45° FOV. CFP. 1380 by 1382 pixels.
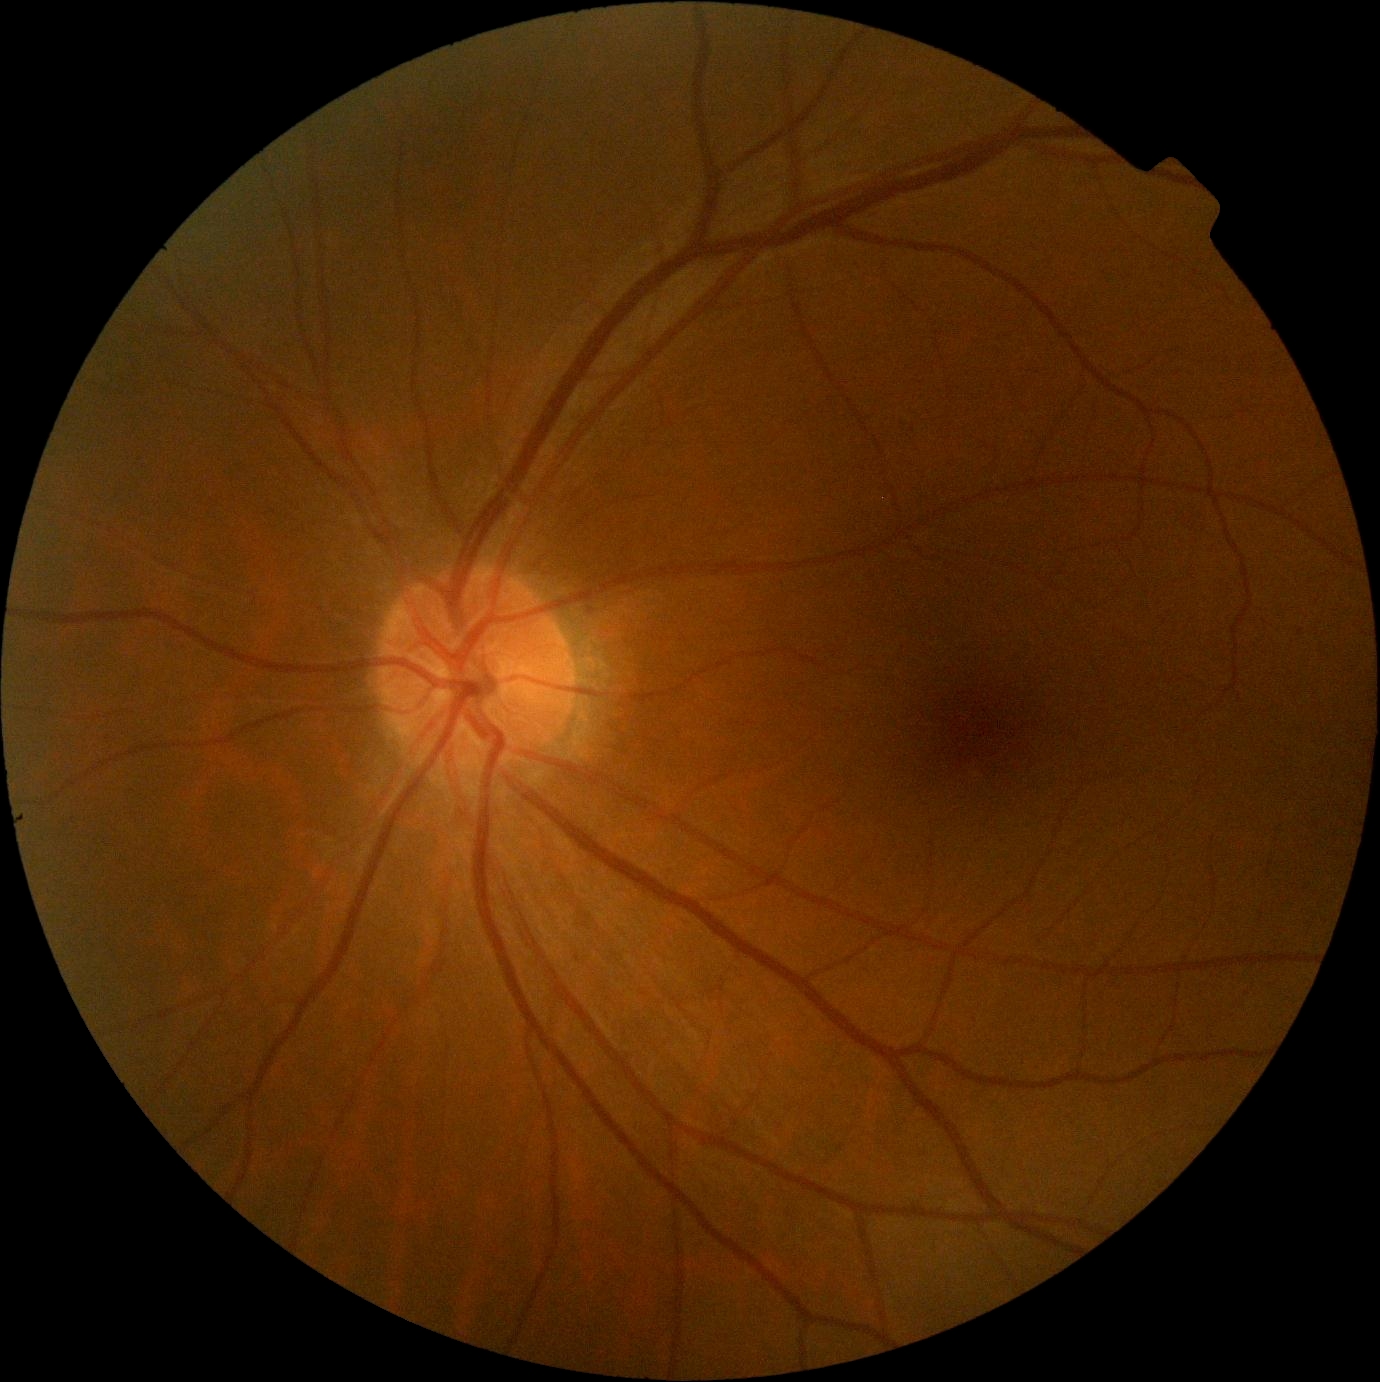
DR severity is no apparent diabetic retinopathy (grade 0). No DR findings.